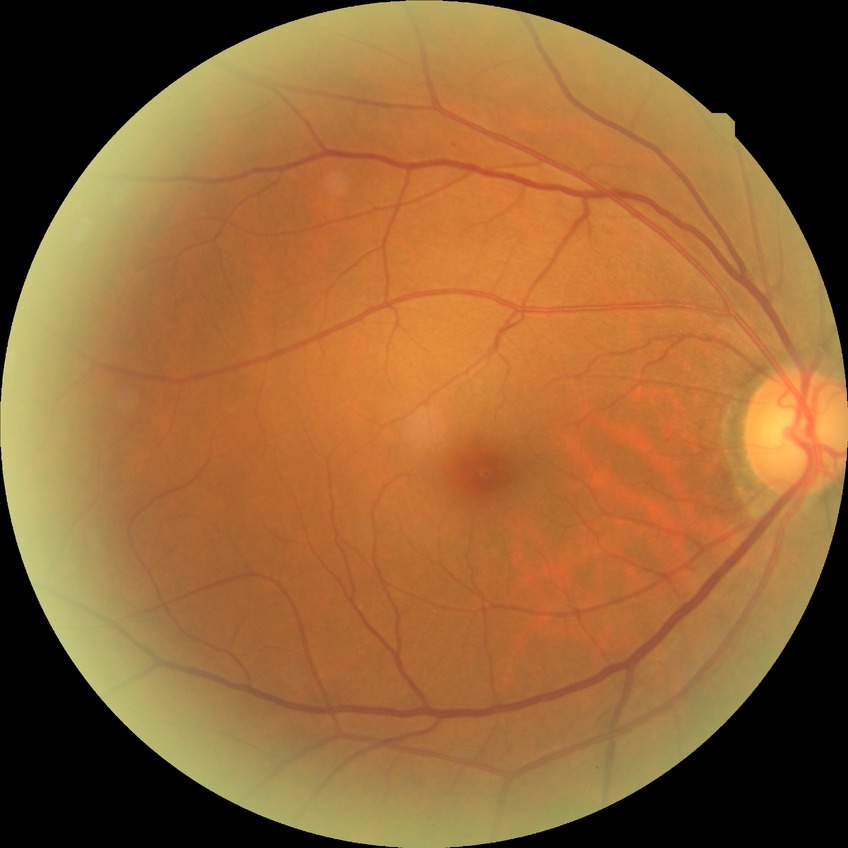
Diabetic retinopathy (DR): NDR (no diabetic retinopathy).